45° FOV
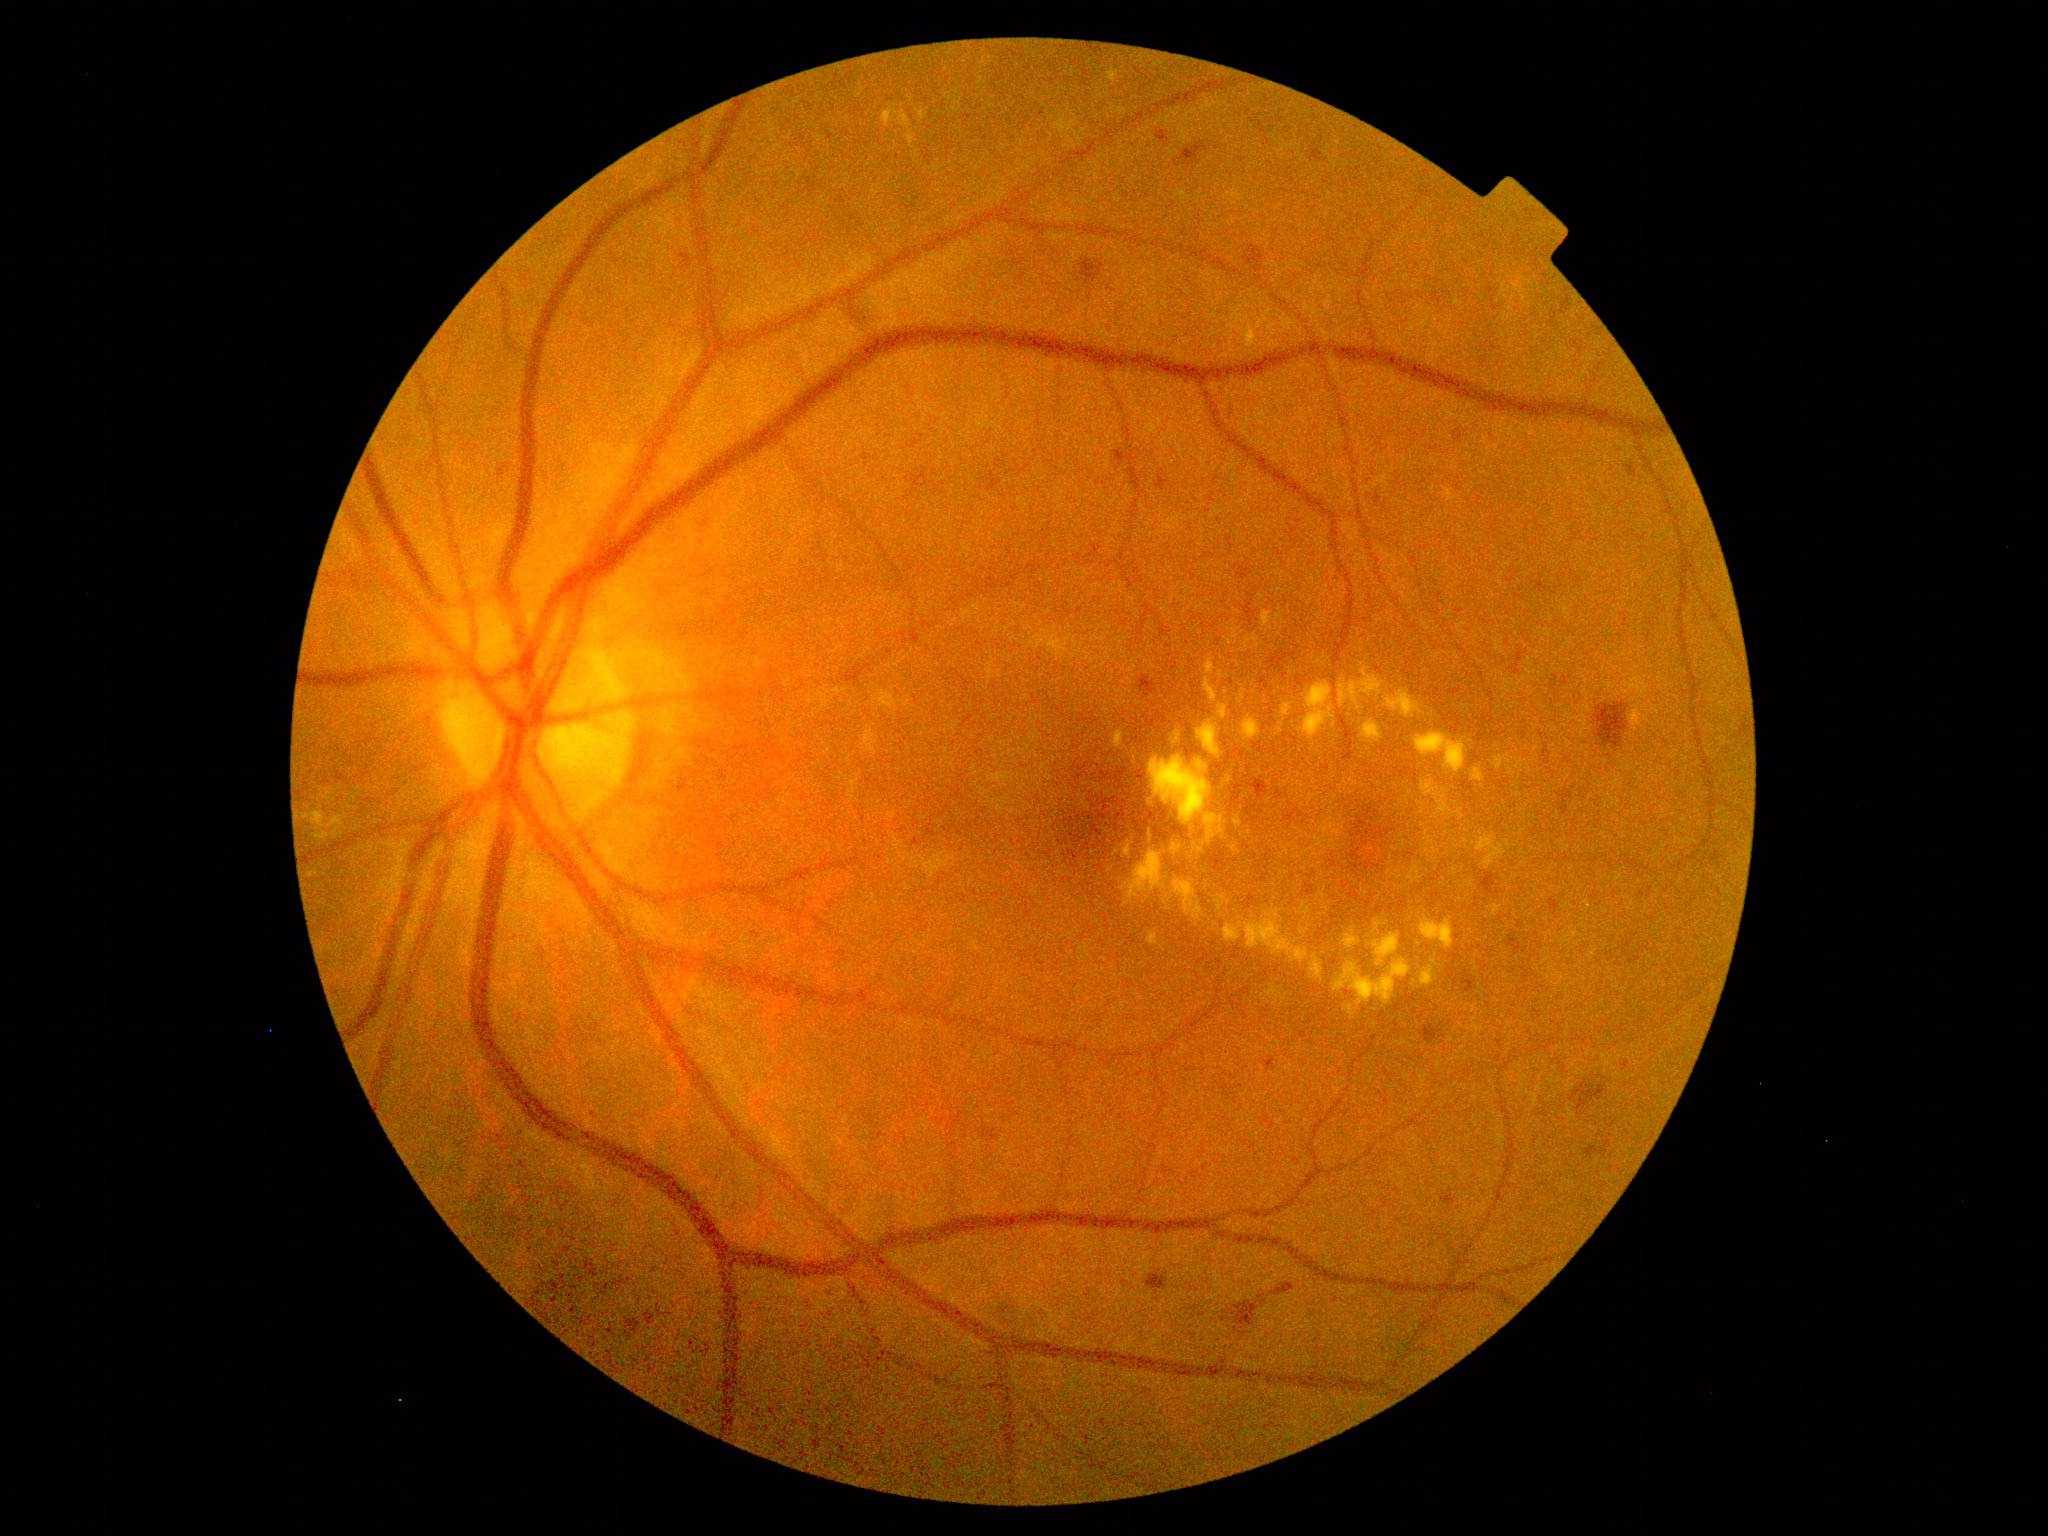
Diabetic retinopathy severity: grade 2 (moderate NPDR)
A subset of detected lesions:
hard exudates (partial): bbox=[1118, 690, 1126, 697]; bbox=[1404, 789, 1413, 803]; bbox=[1457, 809, 1464, 821]; bbox=[1476, 835, 1507, 870]; bbox=[1414, 732, 1469, 775]; bbox=[1373, 919, 1388, 934]; bbox=[1204, 670, 1218, 705]; bbox=[1145, 417, 1162, 437]
Additional small hard exudates near (x=1139, y=704); (x=1269, y=802); (x=1249, y=874); (x=1313, y=774); (x=1318, y=899); (x=1423, y=812); (x=1482, y=832); (x=1125, y=1005); (x=1498, y=673); (x=1170, y=900); (x=1477, y=969)
hemorrhages (partial): bbox=[586, 1260, 598, 1277]; bbox=[1133, 770, 1148, 785]; bbox=[1080, 259, 1105, 283]; bbox=[1354, 818, 1370, 846]; bbox=[1162, 1164, 1172, 1174]; bbox=[1101, 767, 1133, 800]; bbox=[1245, 806, 1264, 823]; bbox=[1367, 826, 1393, 841]; bbox=[1343, 882, 1351, 889]; bbox=[1350, 889, 1360, 902]; bbox=[1116, 825, 1126, 833]; bbox=[1072, 835, 1088, 845]; bbox=[1274, 1283, 1295, 1296]; bbox=[1242, 604, 1258, 626]
Additional small hemorrhages near (x=1111, y=827); (x=1106, y=840); (x=1081, y=832); (x=1357, y=873)